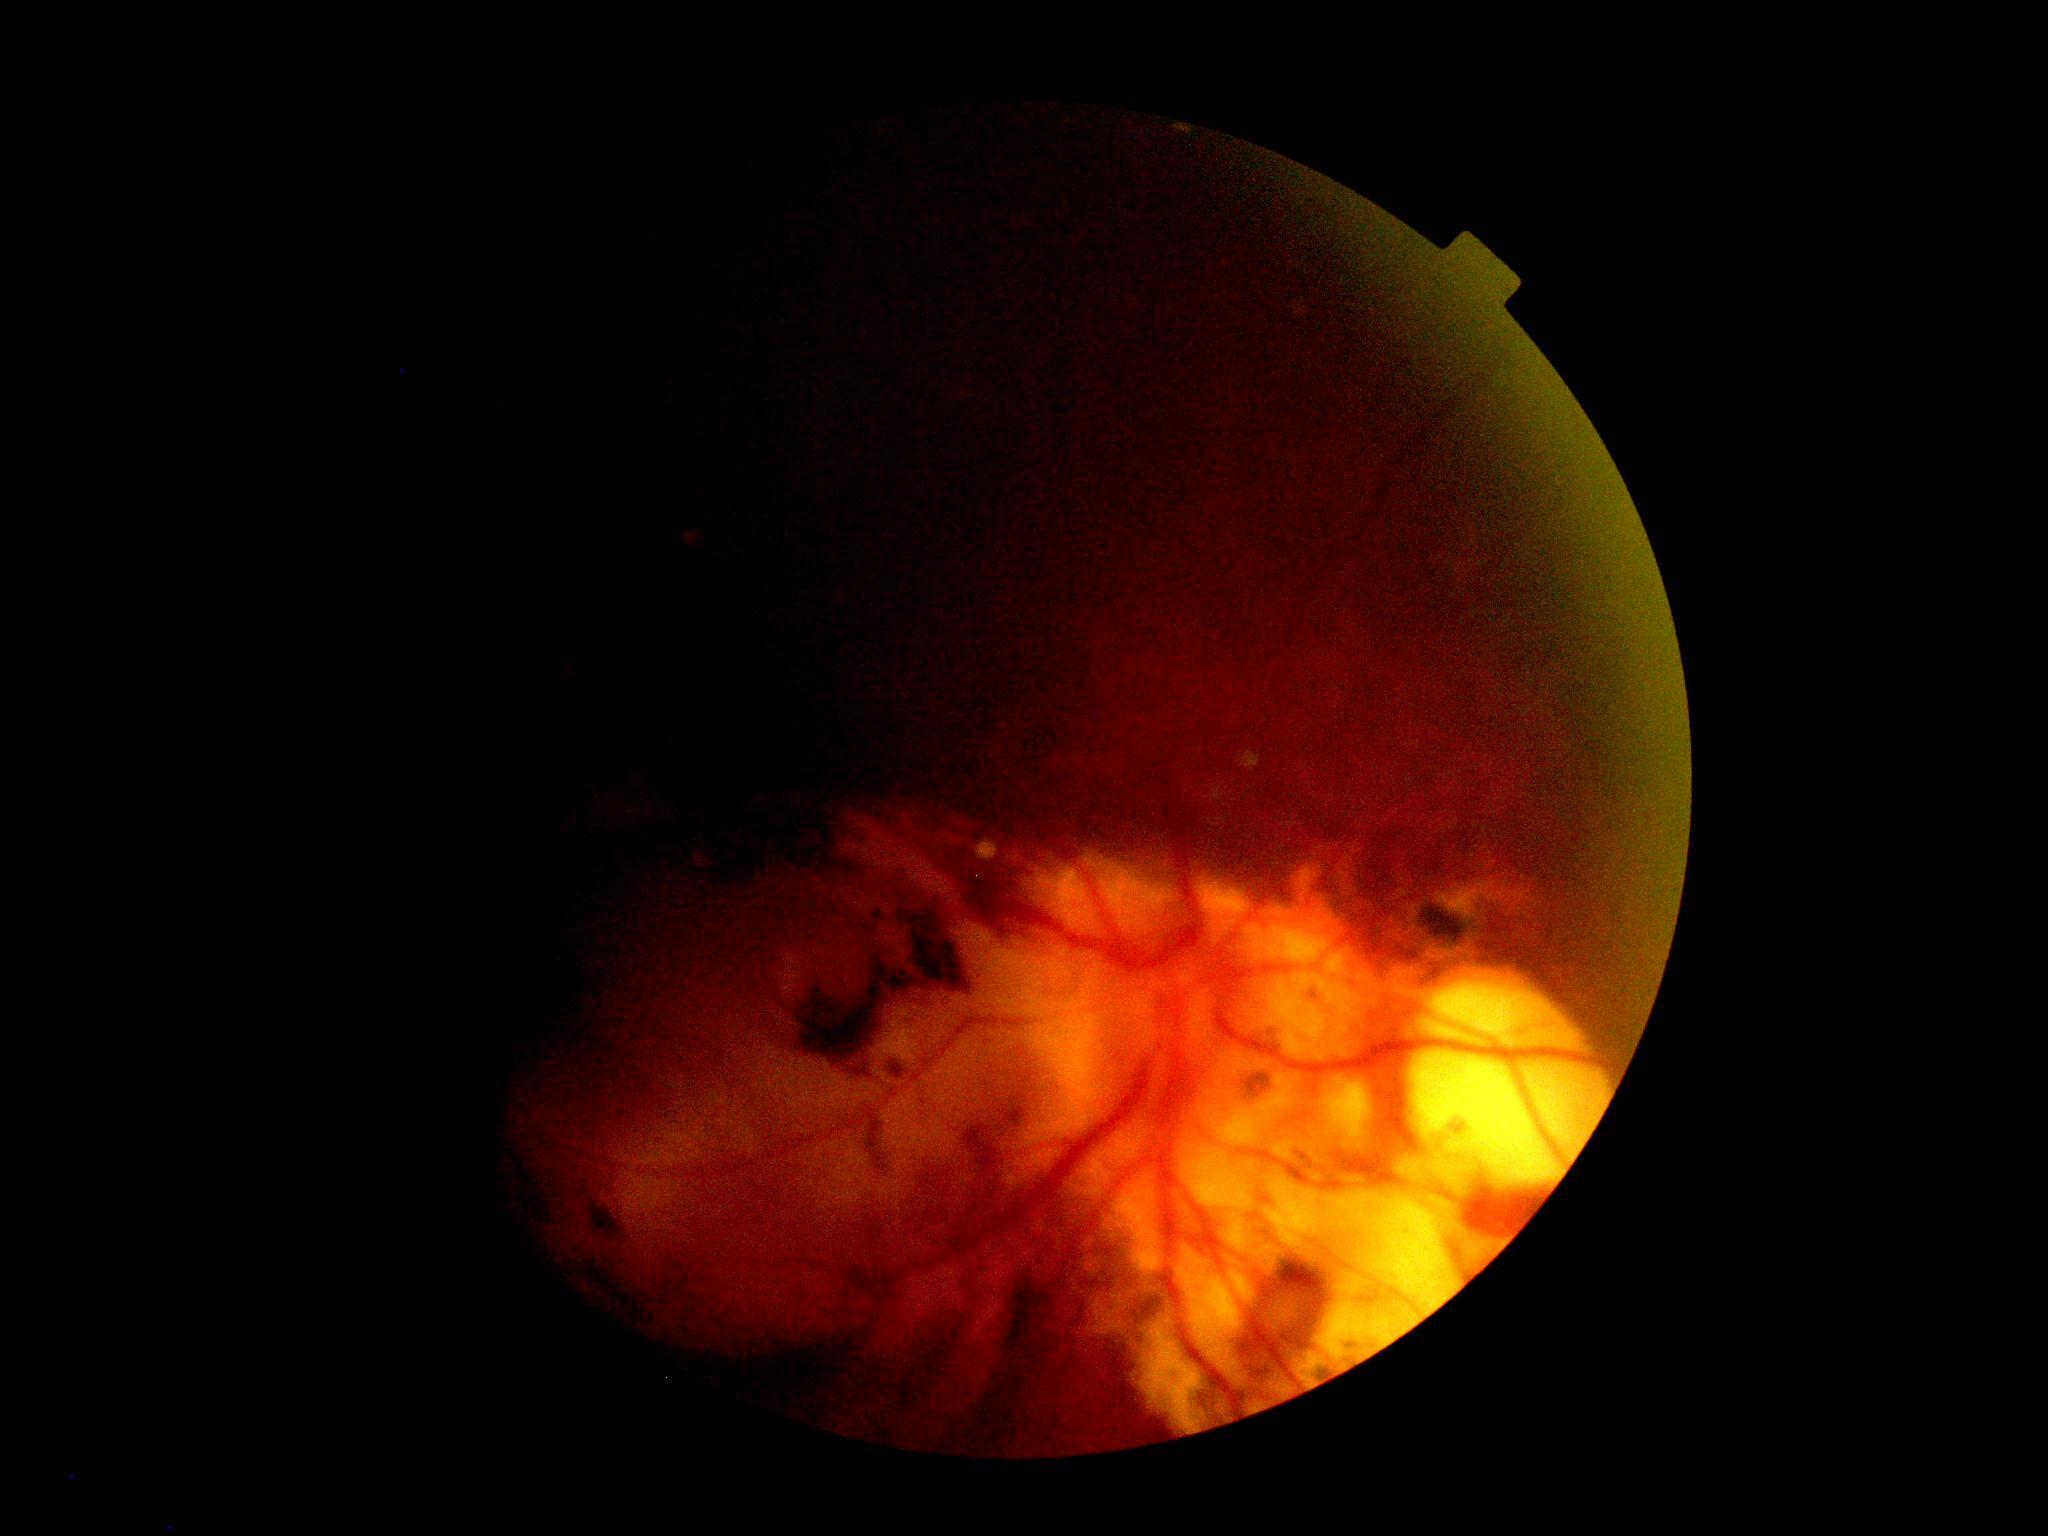 Diabetic retinopathy (DR): ungradable.